Pediatric retinal photograph (wide-field).
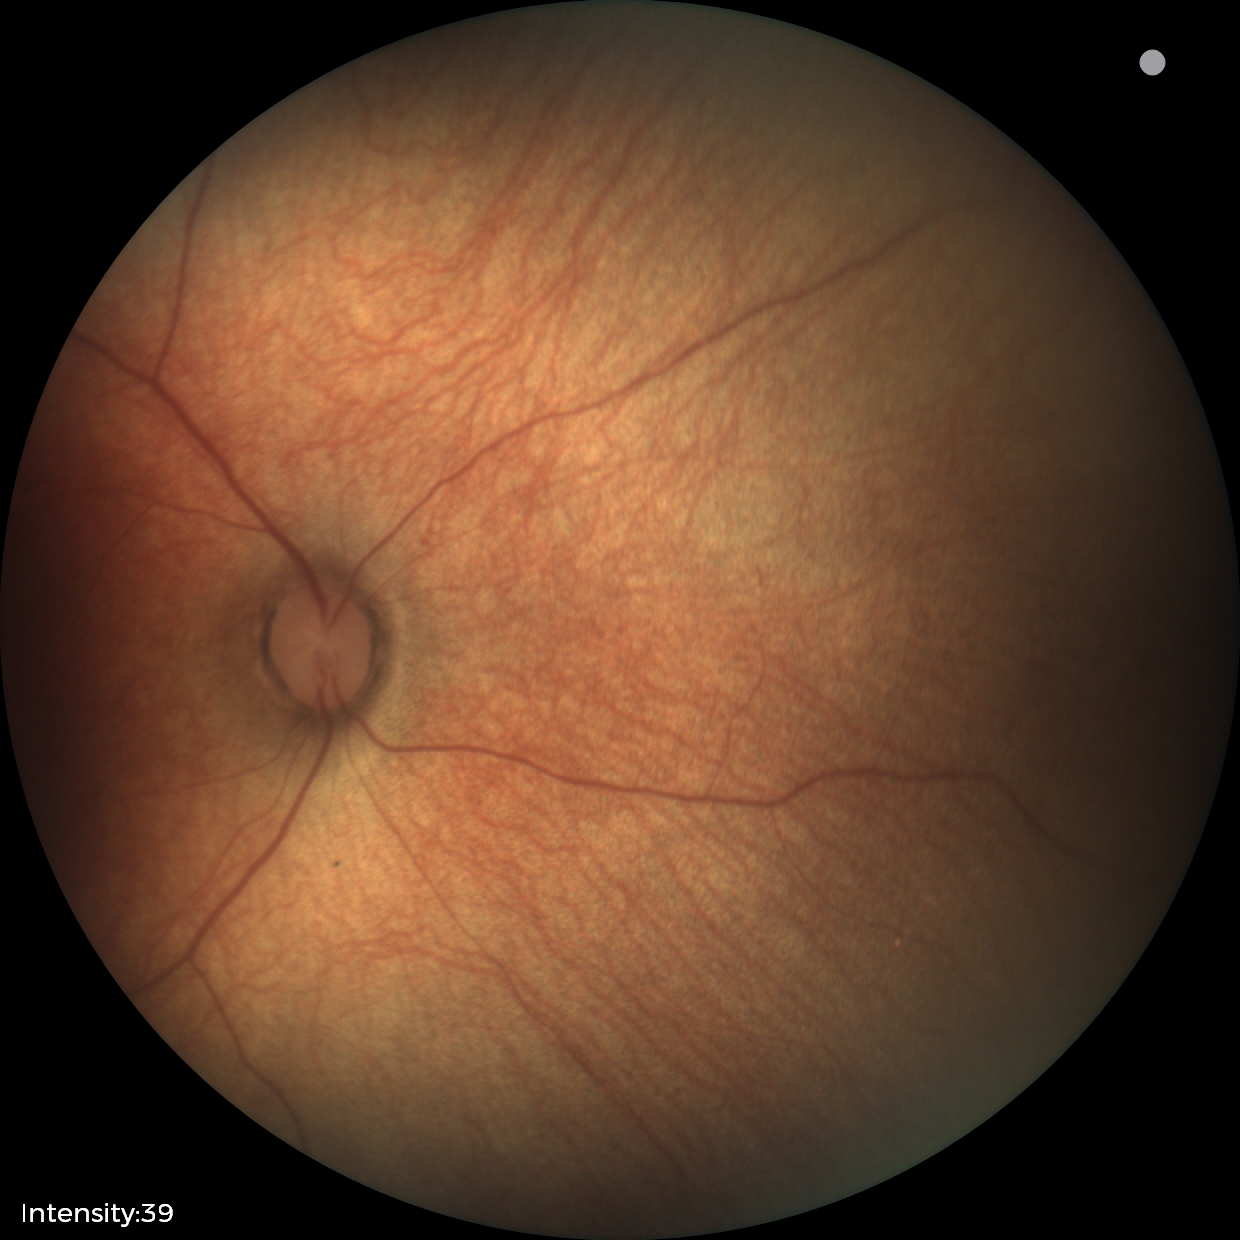
Impression: normal retinal appearance.